CFP, image size 2352x1568.
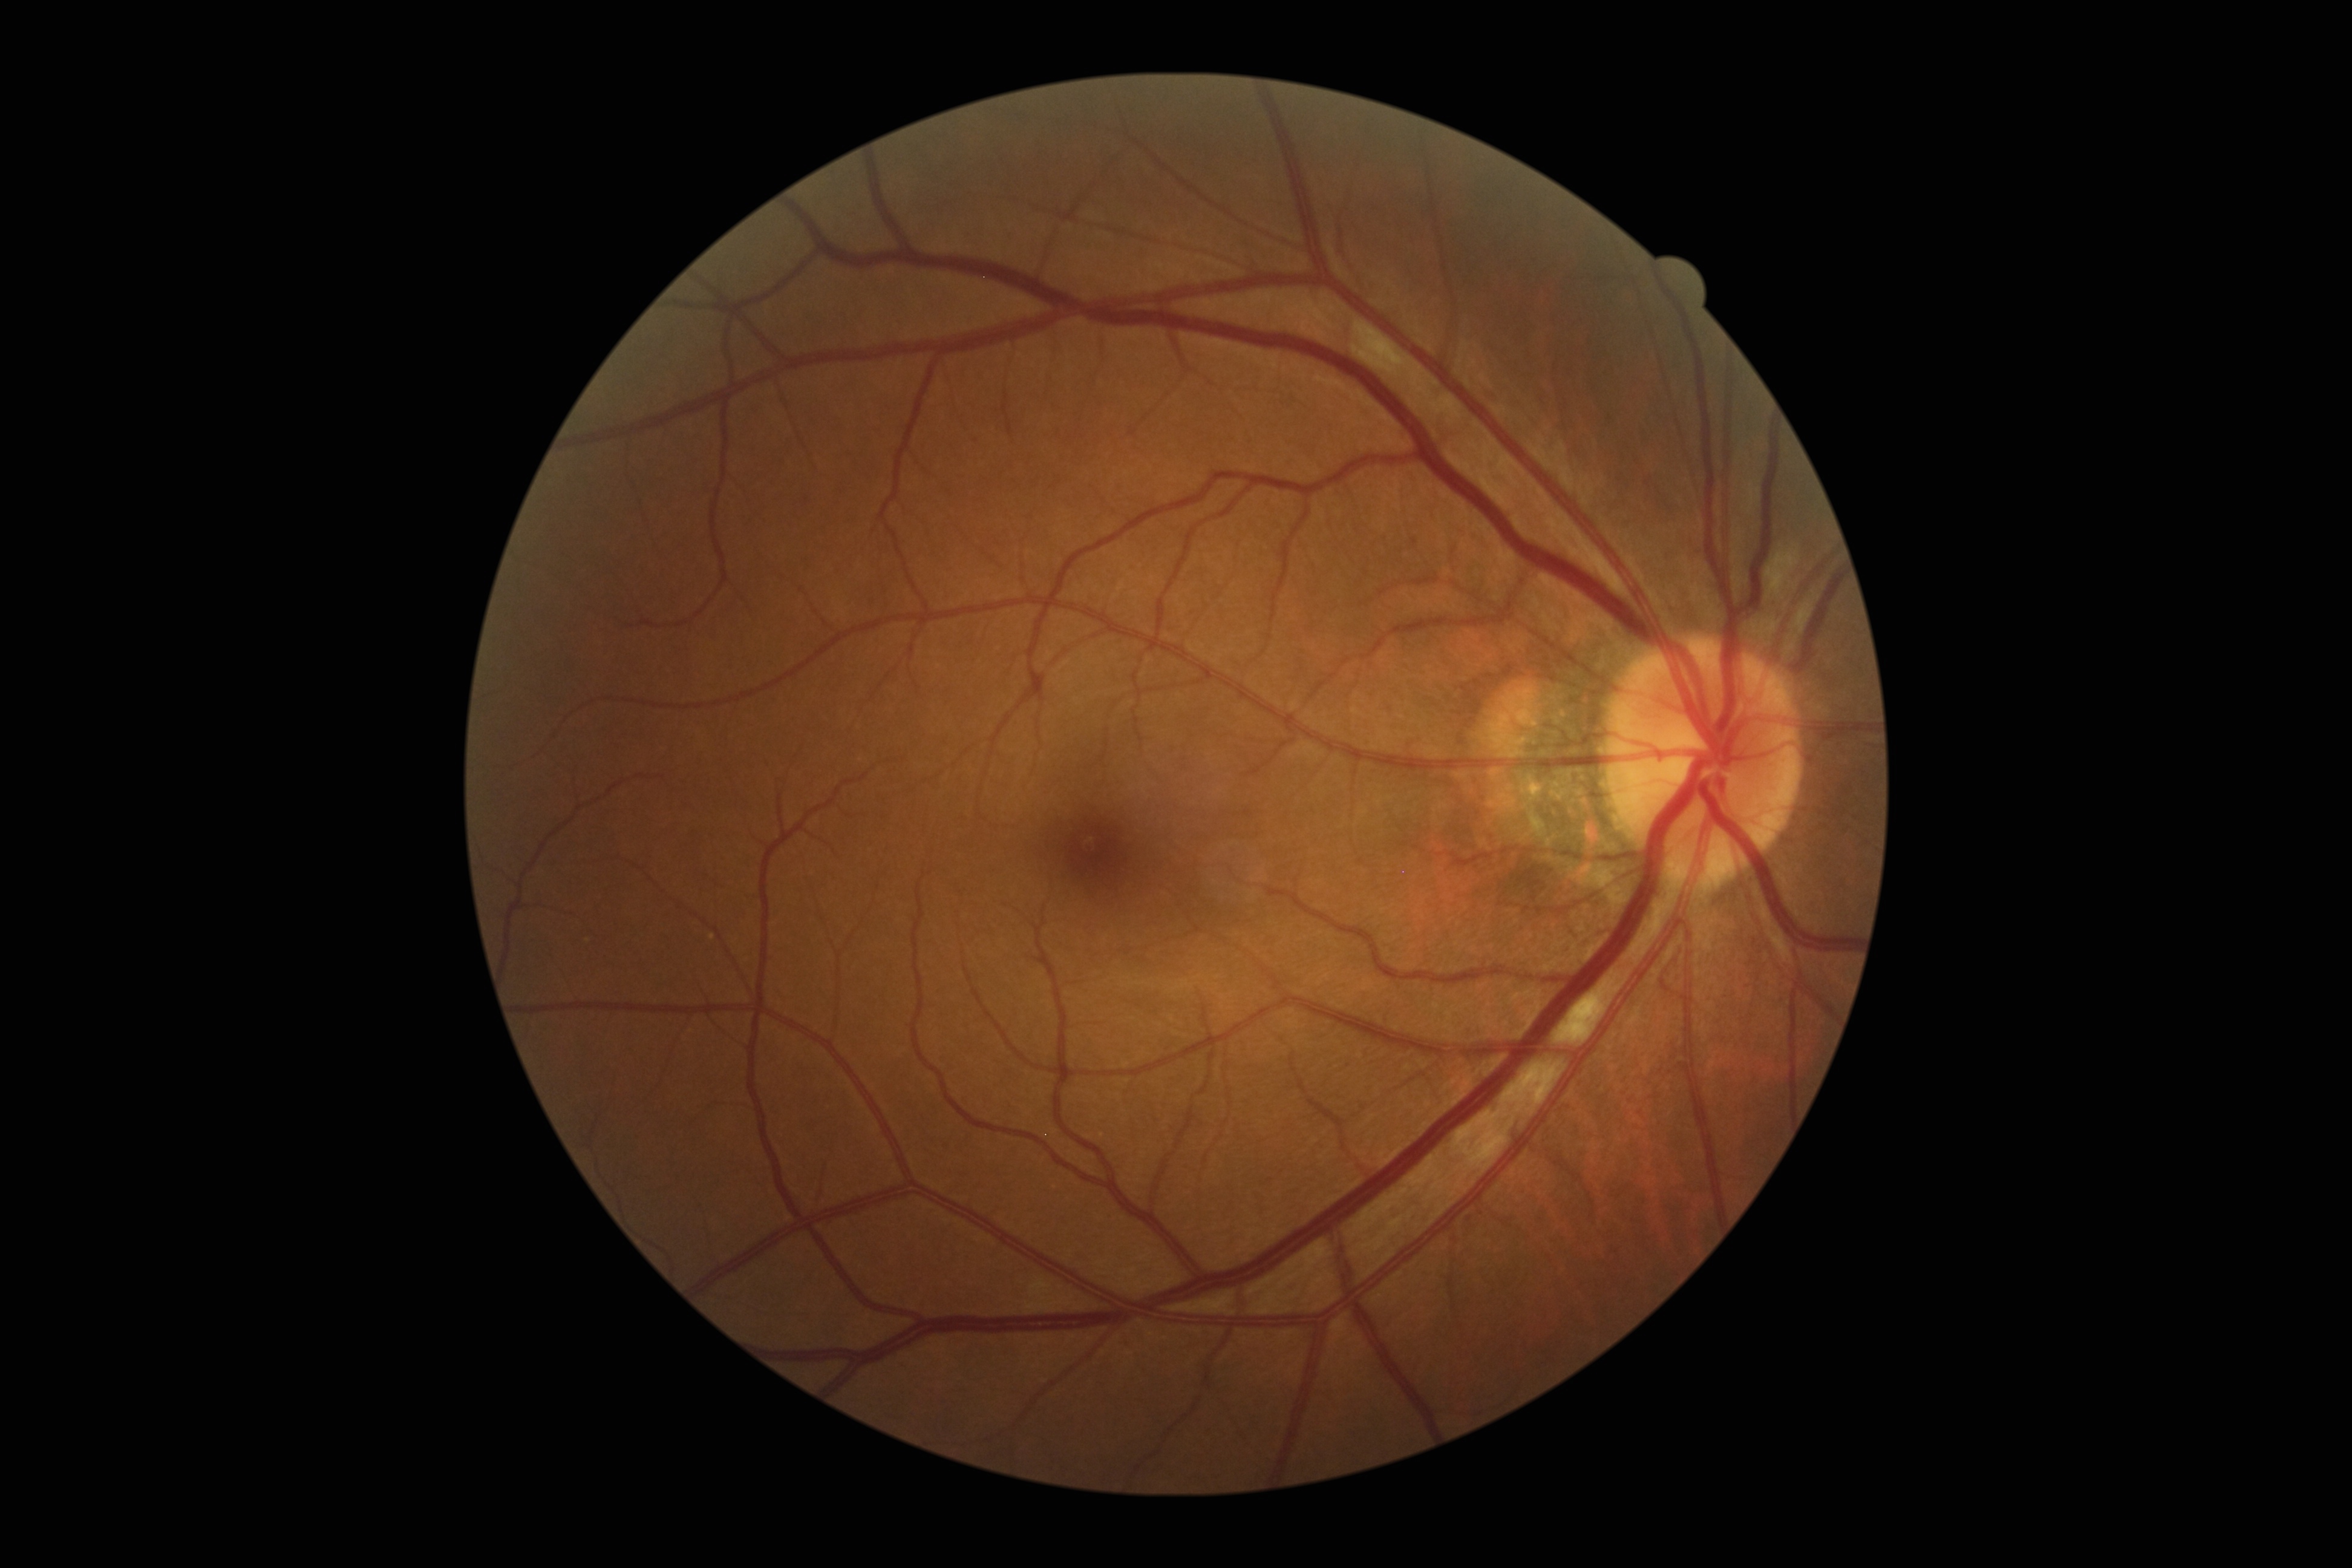

{"dr_grade": "grade 2 (moderate NPDR)"}